1240 x 1240 pixels · wide-field contact fundus photograph of an infant:
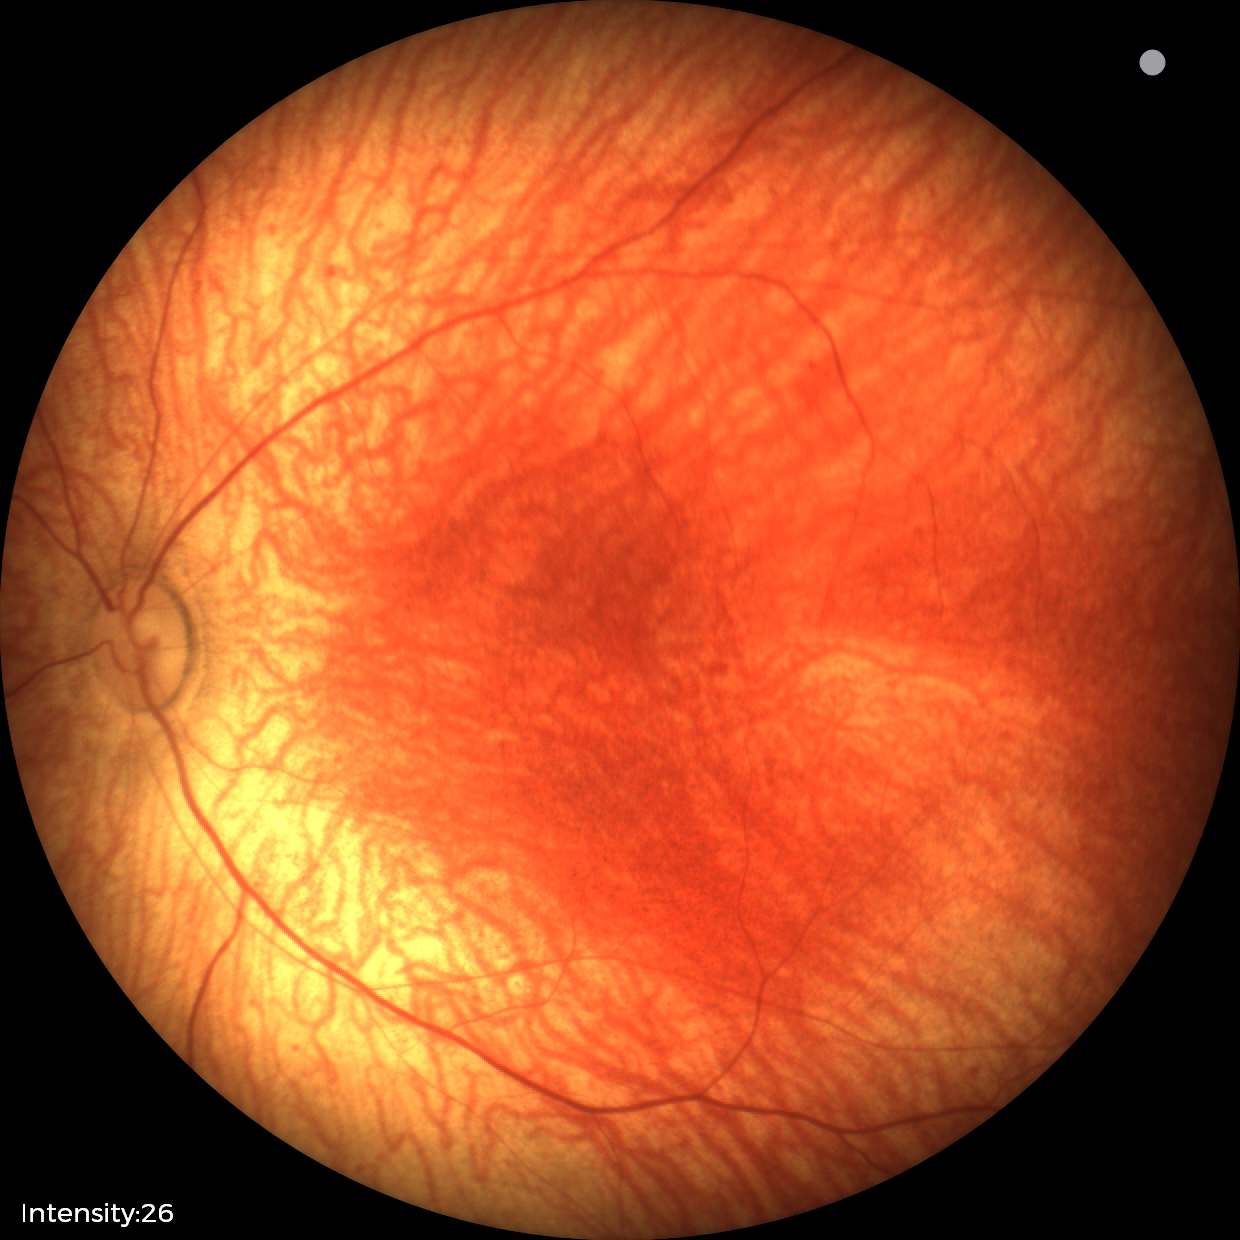

Q: What was the screening finding?
A: no abnormal retinal findings